Fundus photo, 45° FOV: 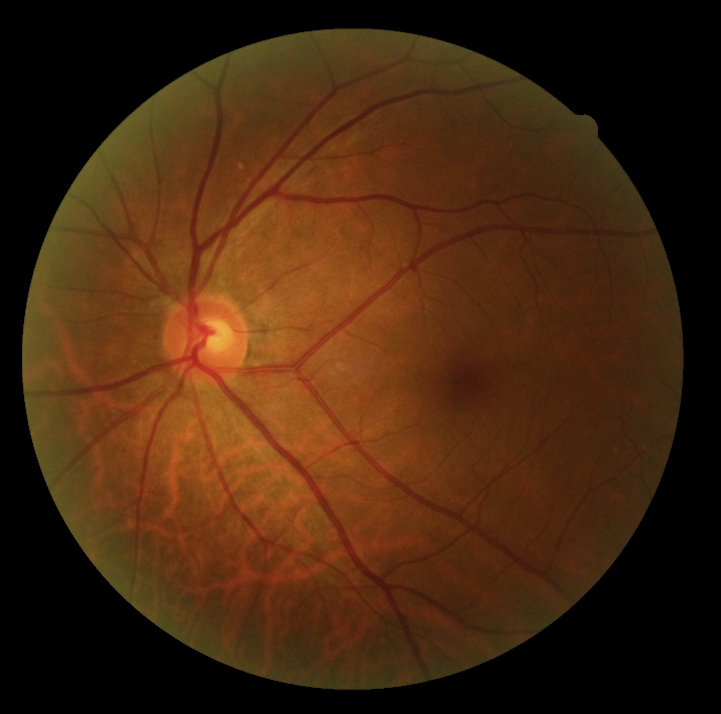

DR impression: no apparent DR | diabetic retinopathy severity: 0.